Retinal fundus photograph; 2048 x 1536 pixels — 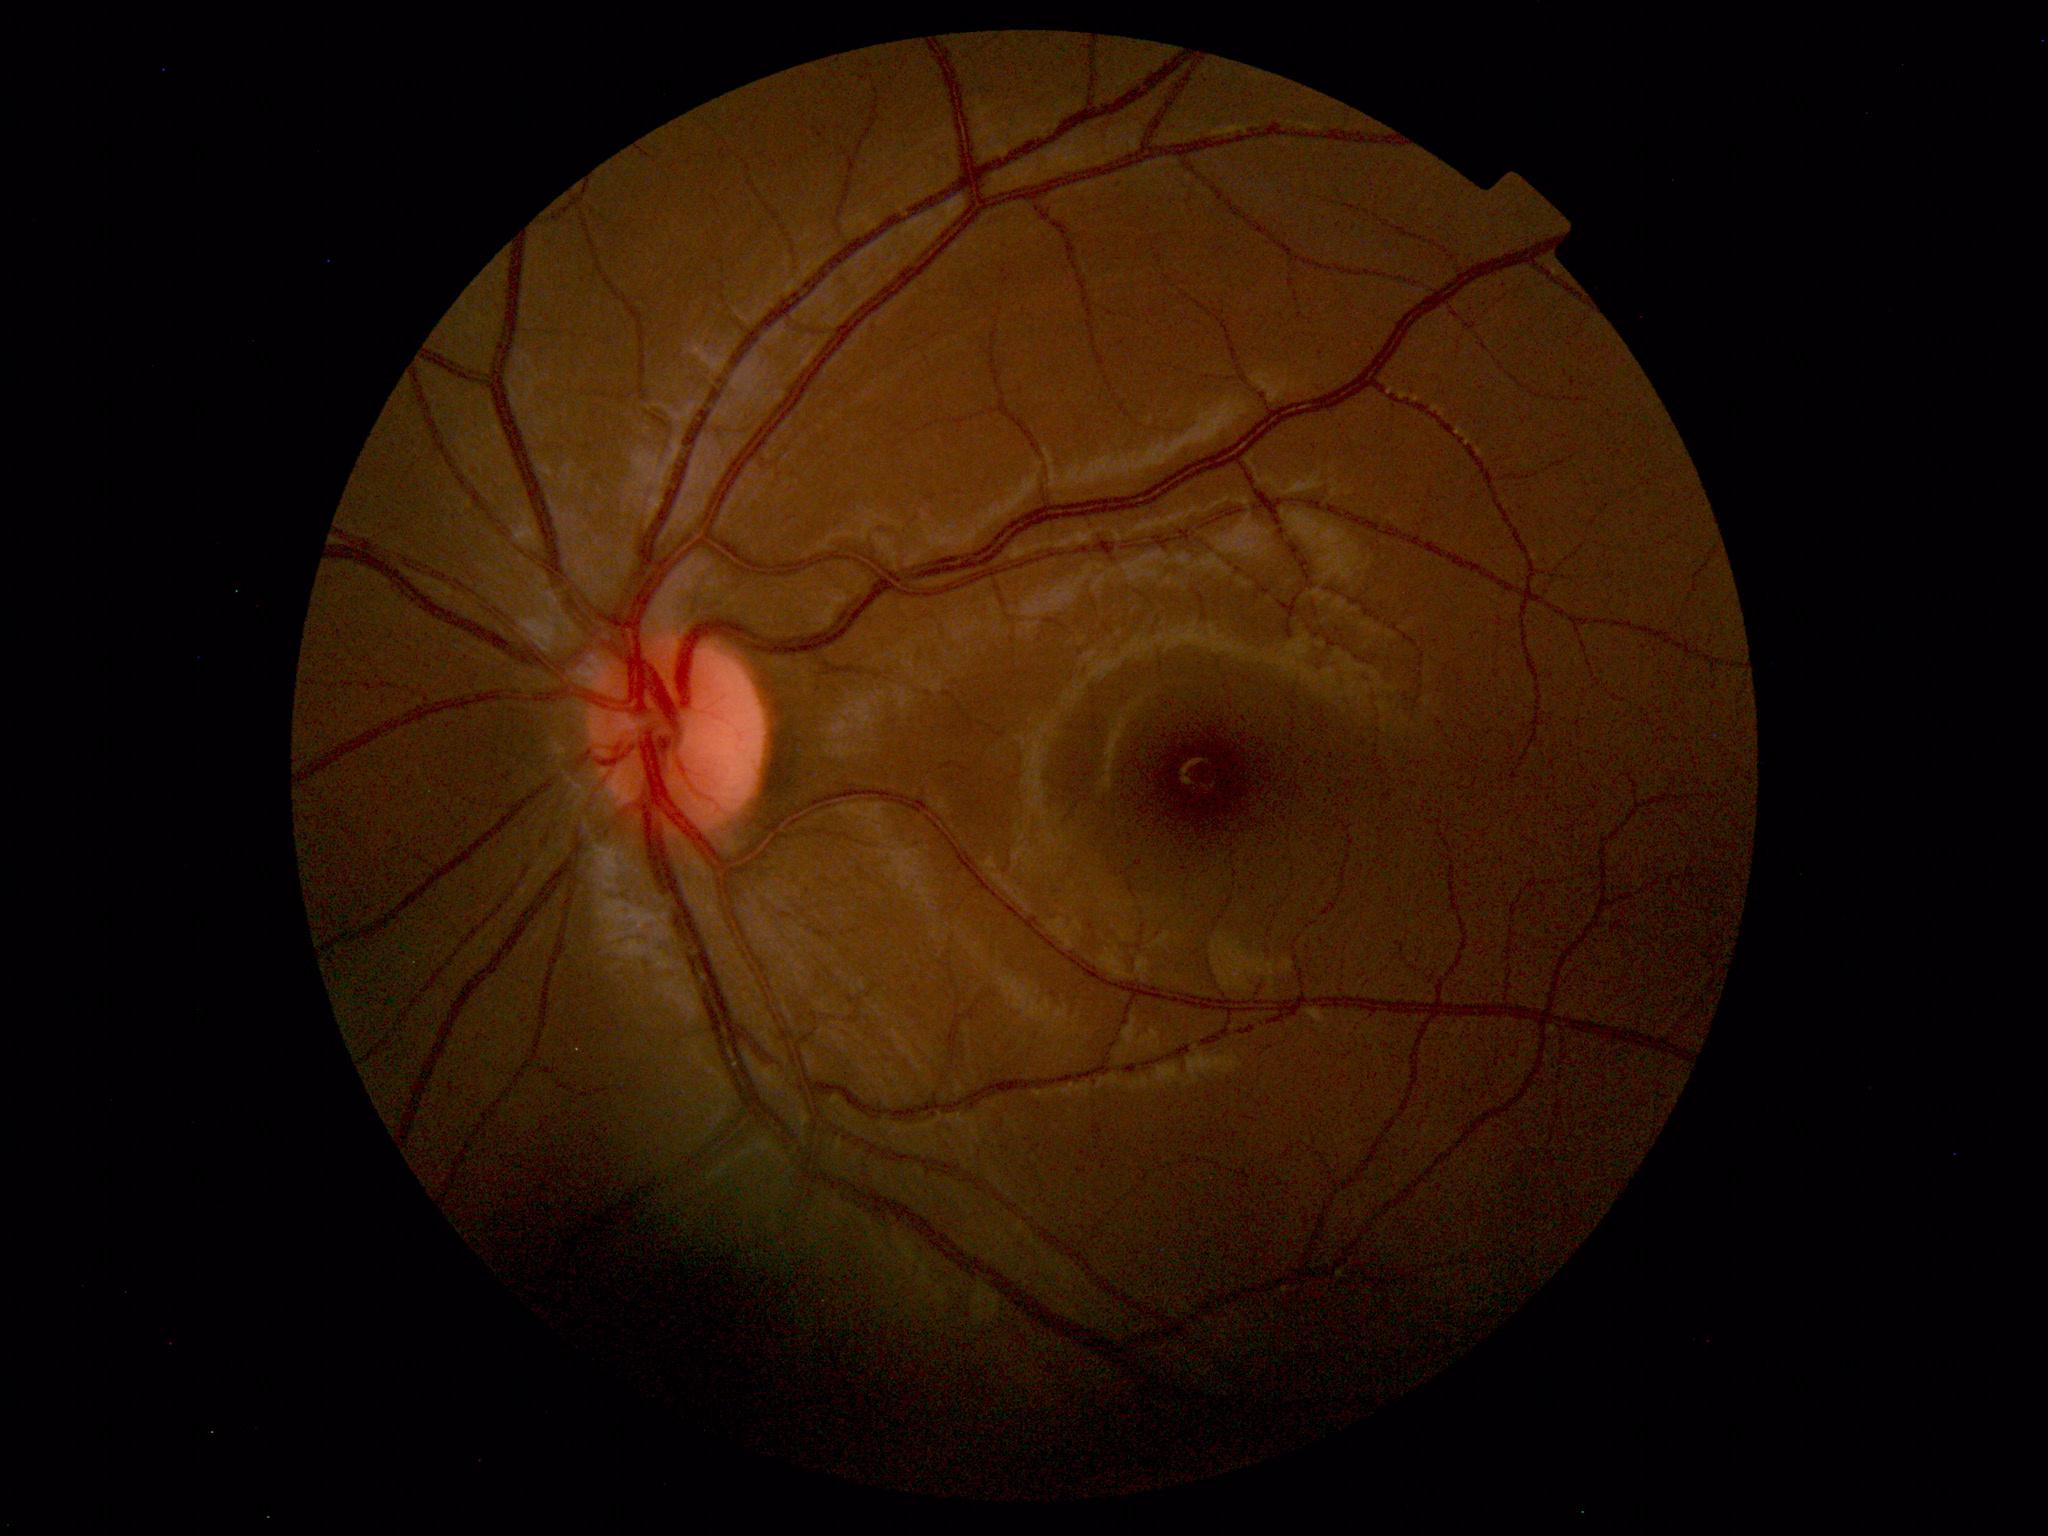 Findings: no abnormalities.